Image size 1932x1906; CFP — 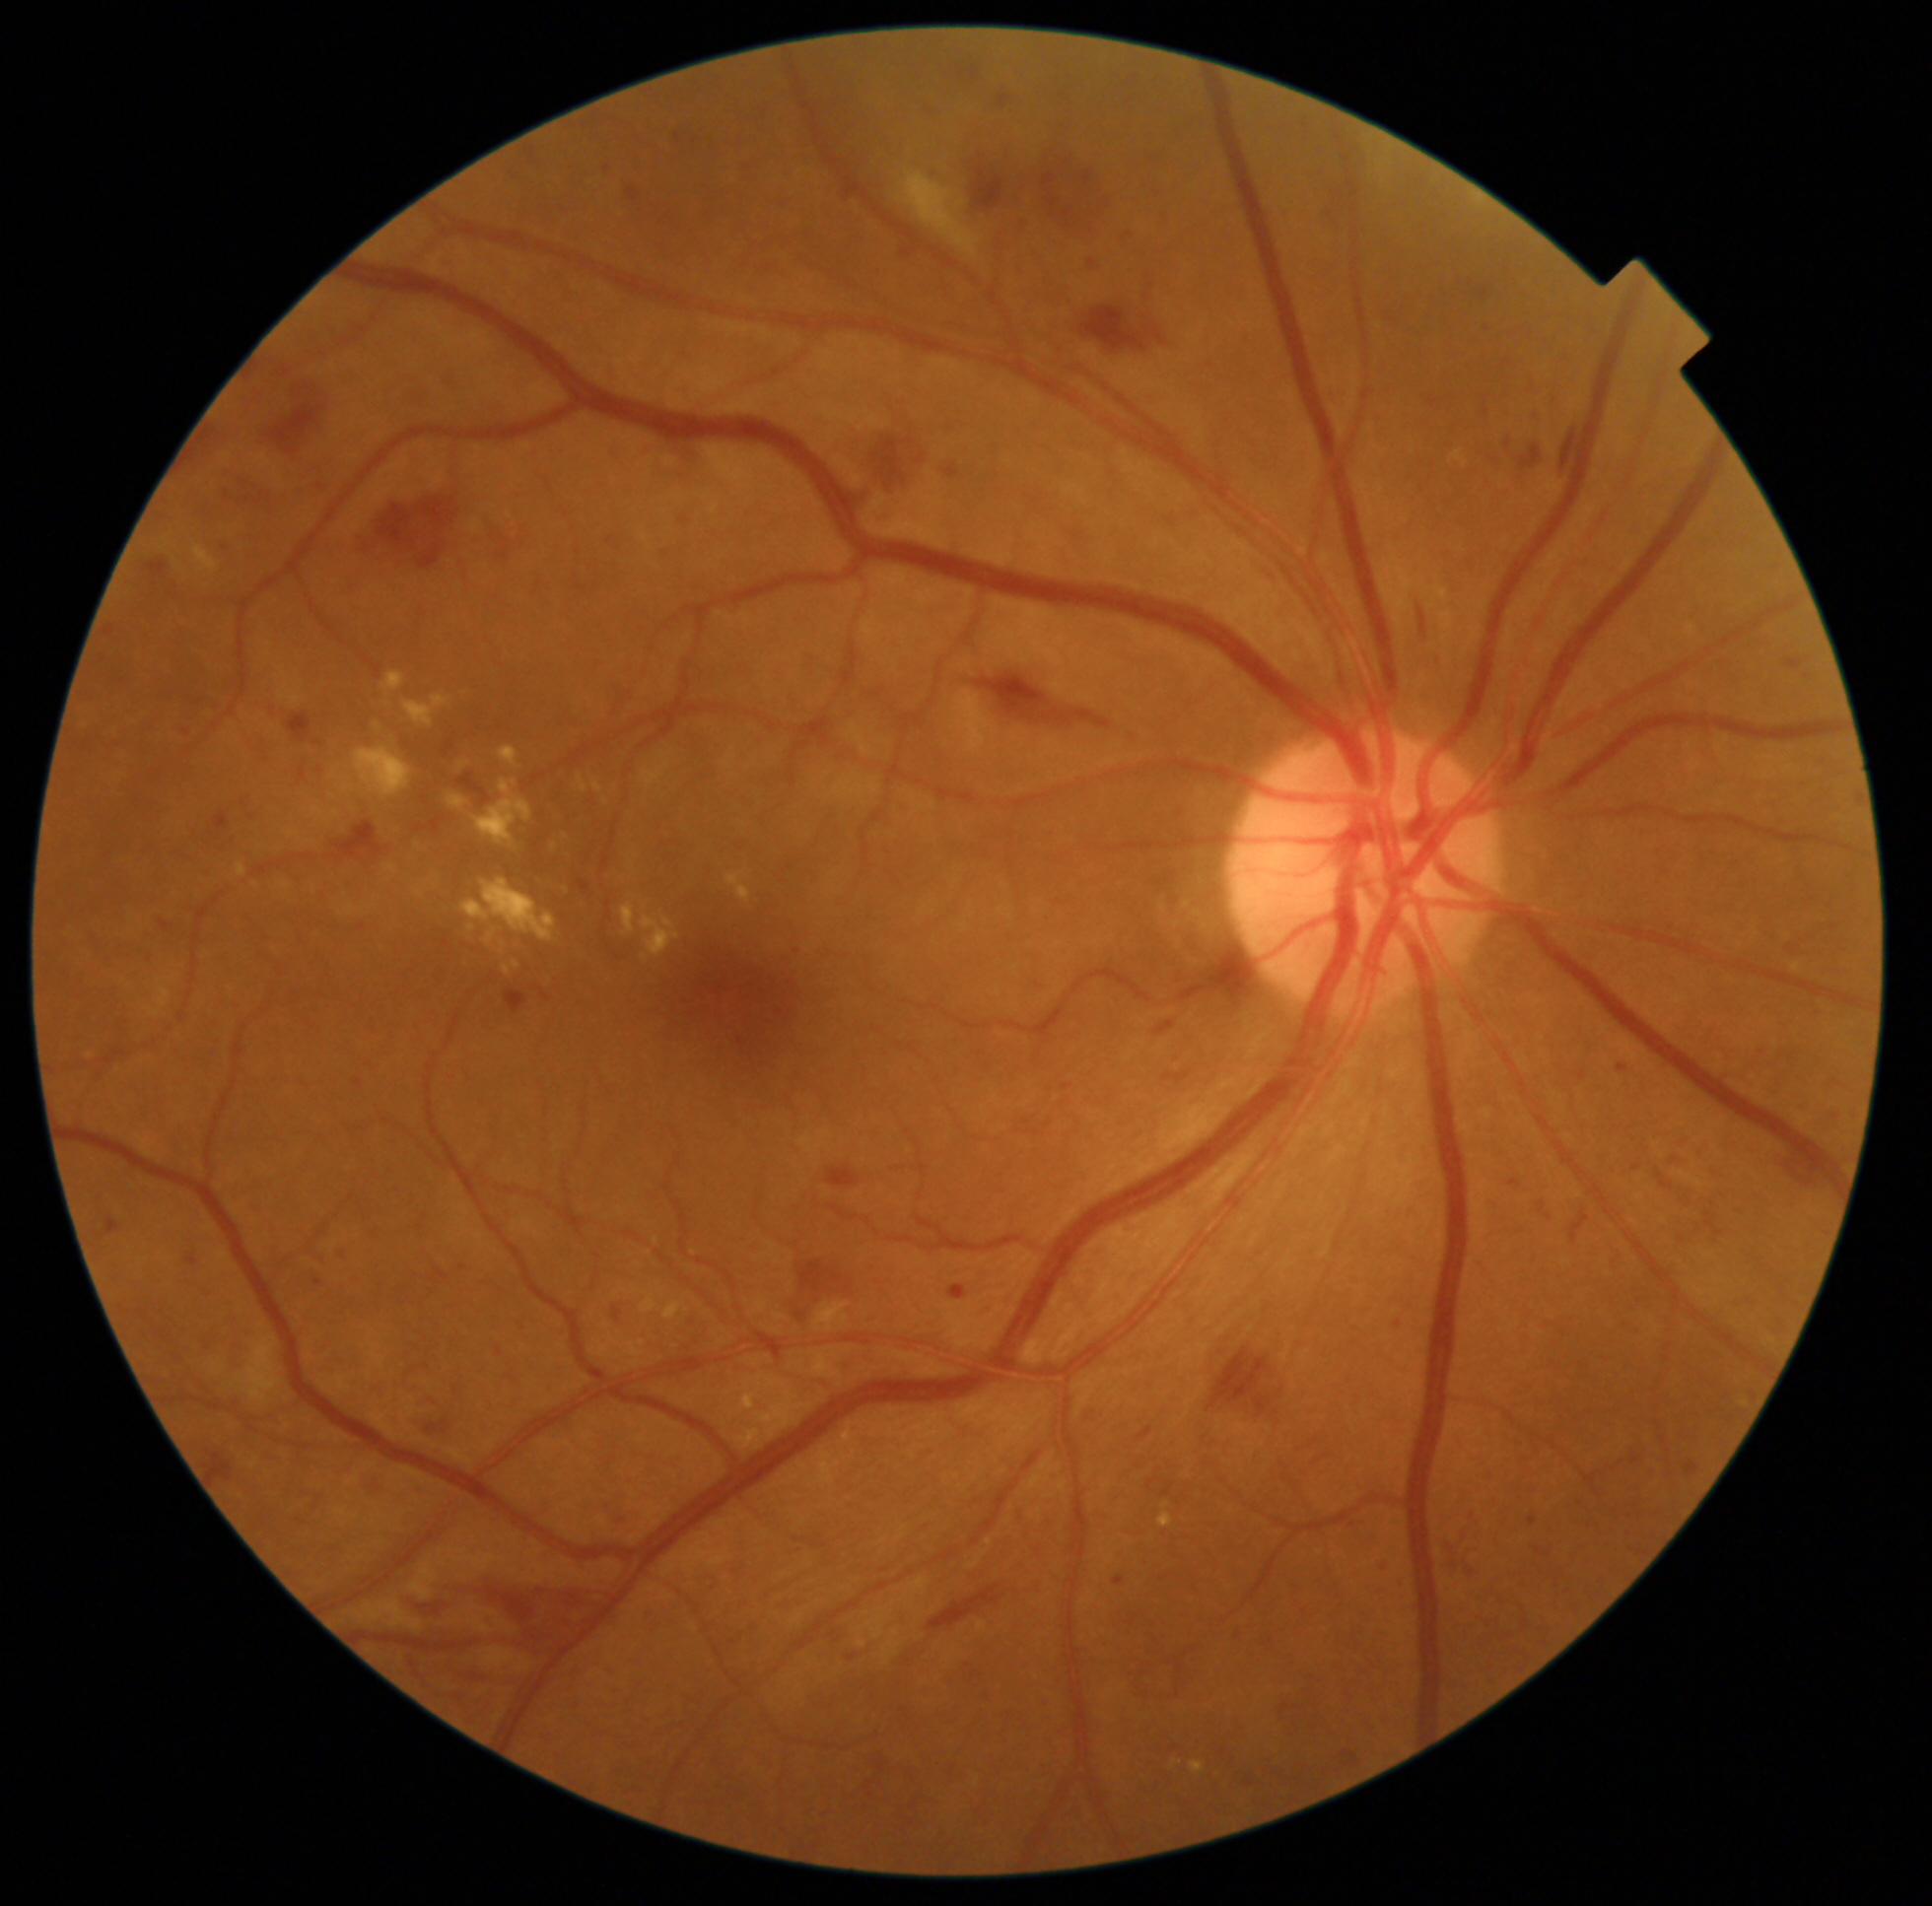

Findings: moderate non-proliferative diabetic retinopathy.